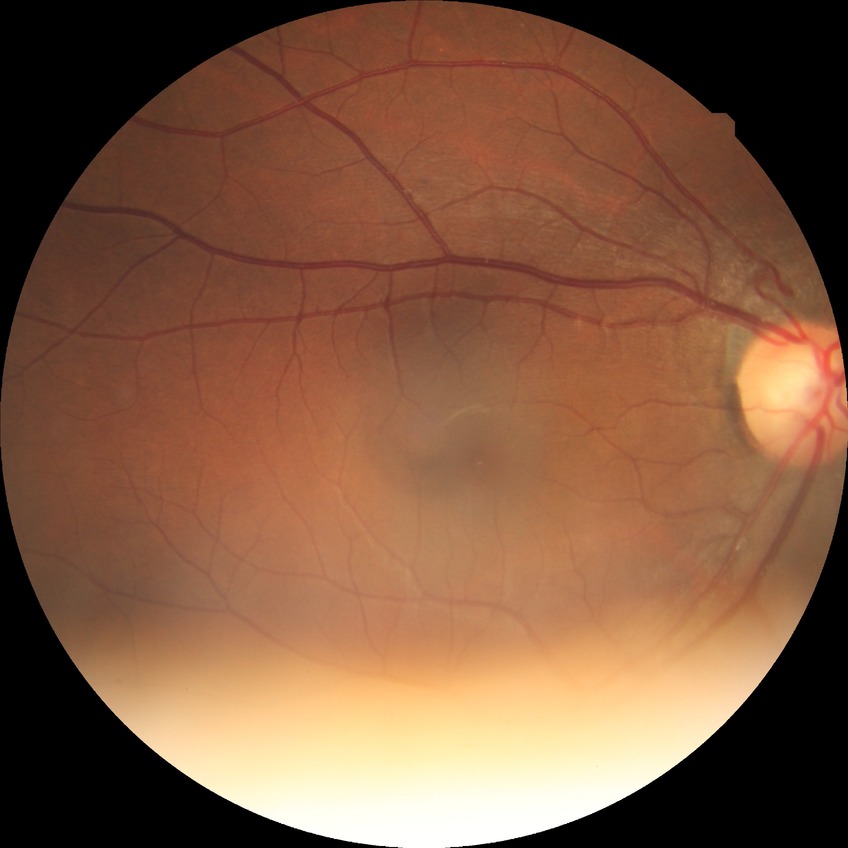 davis_grade: no diabetic retinopathy